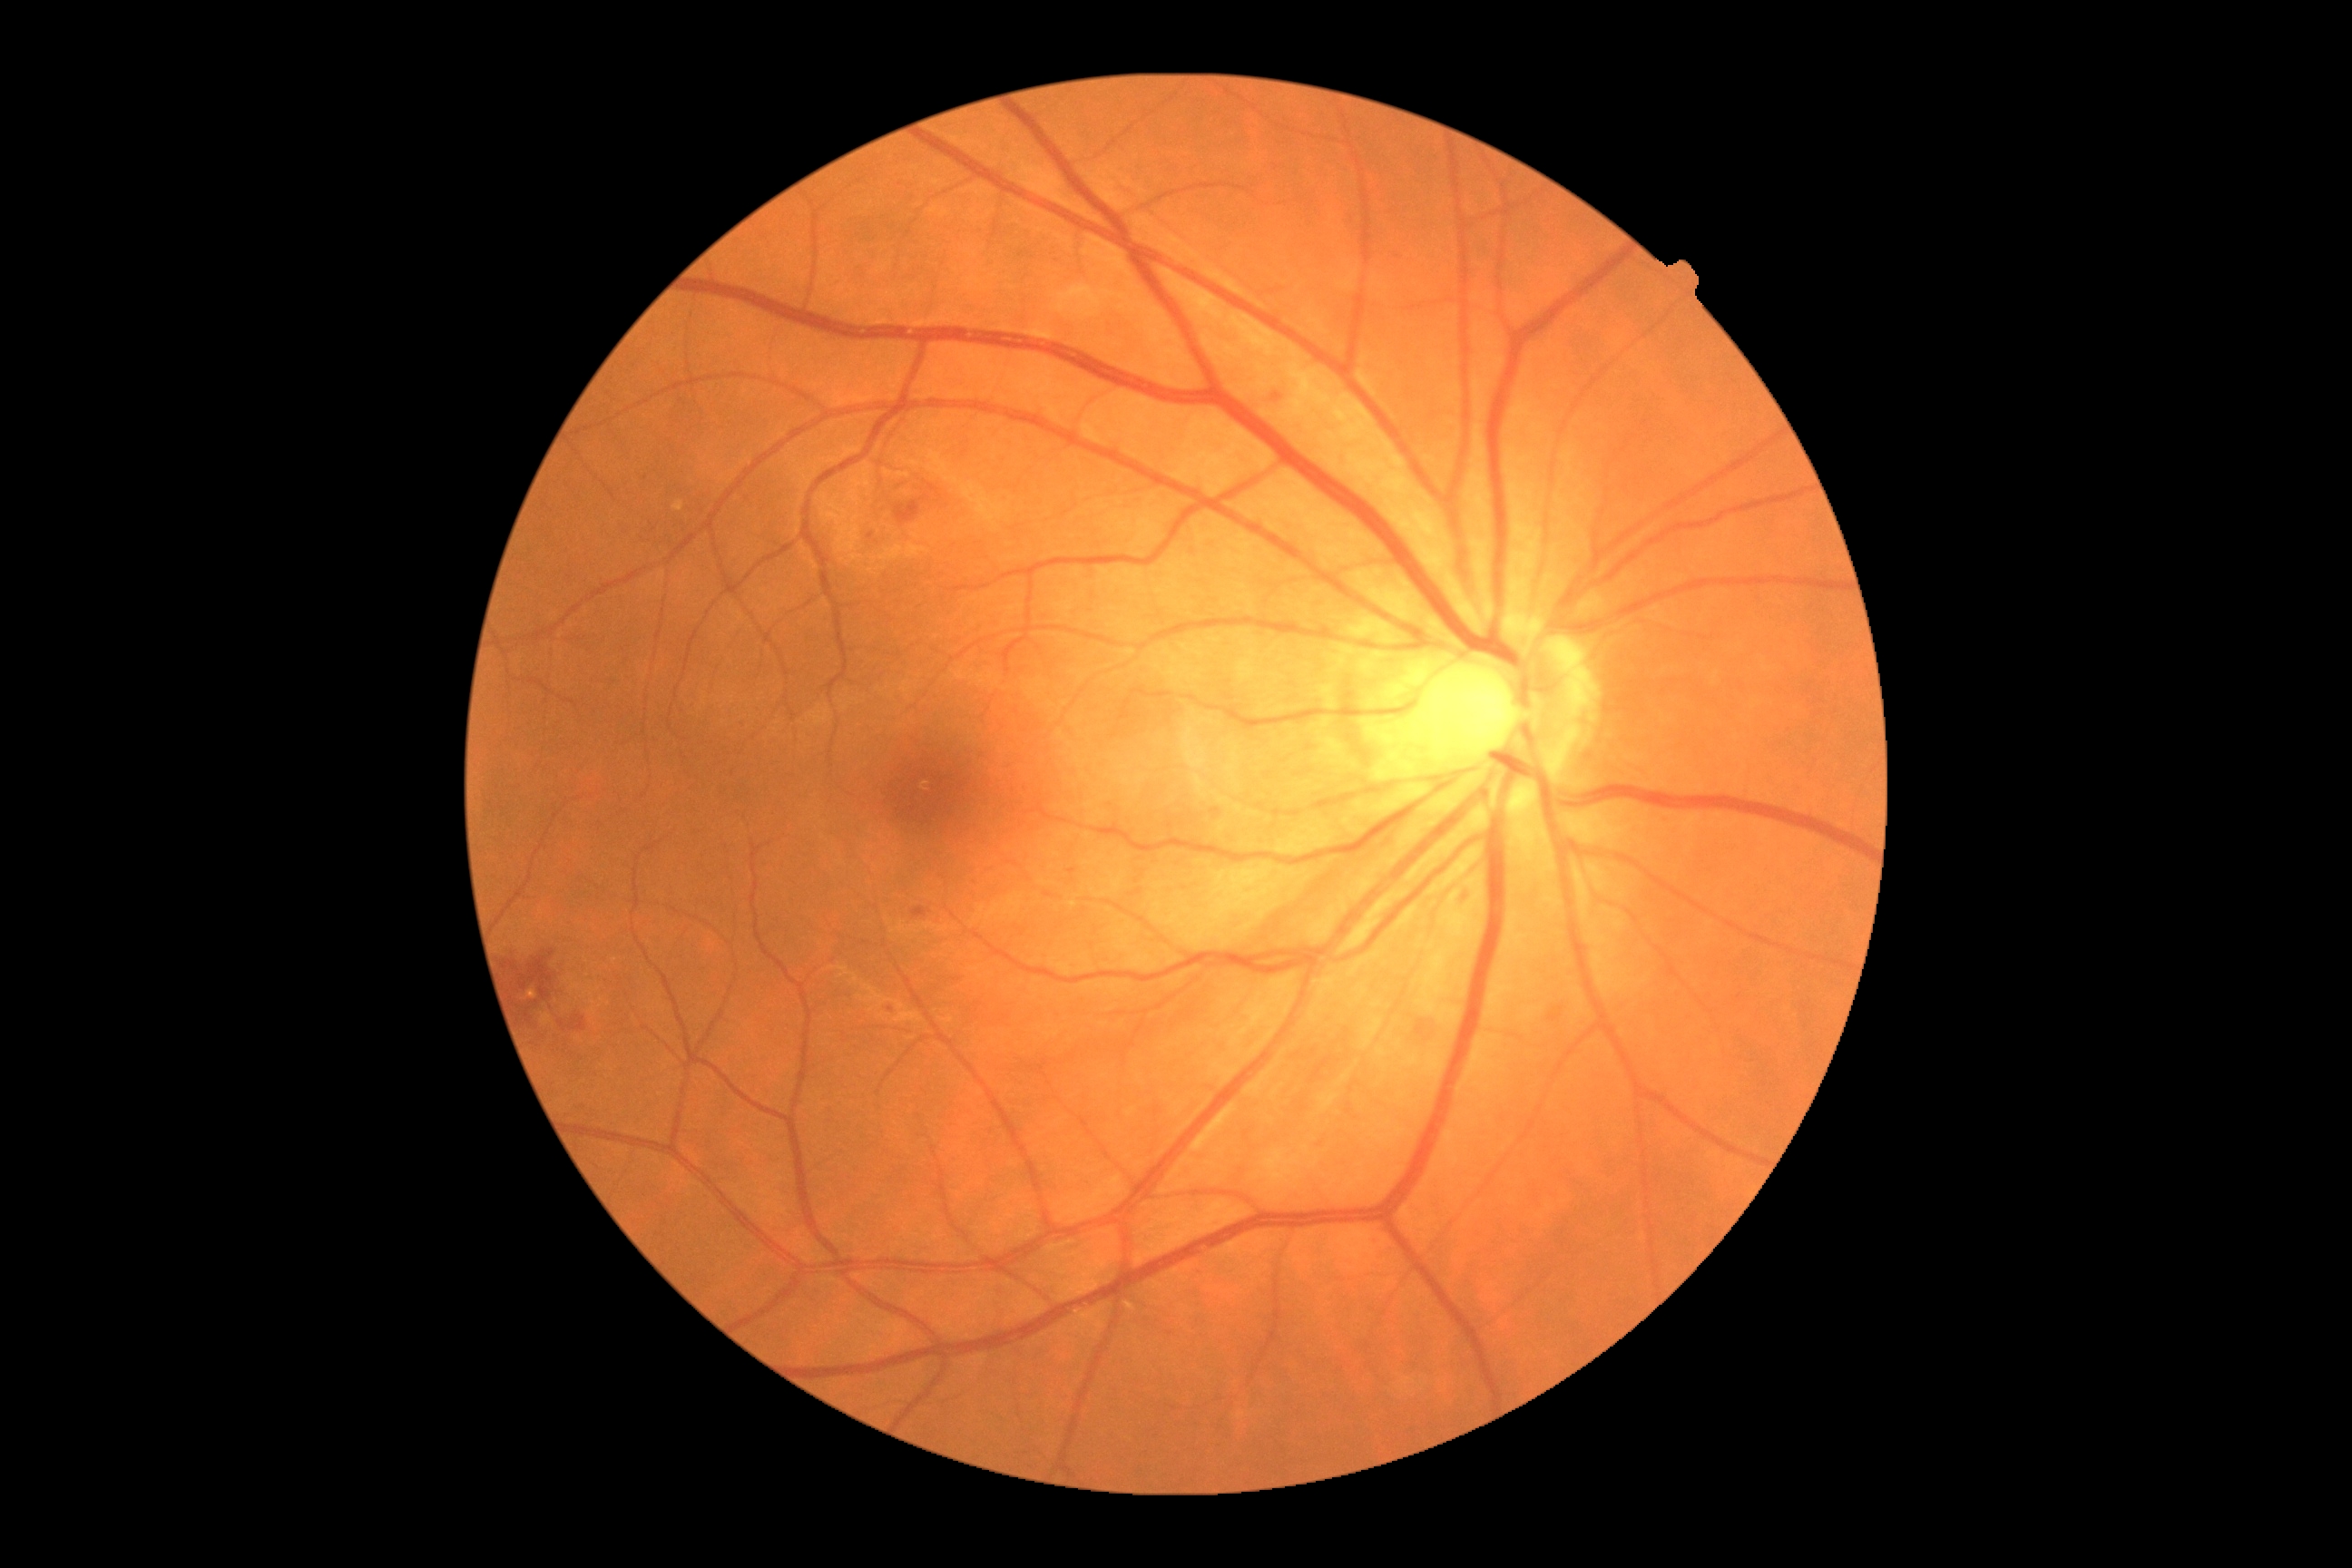

Diabetic retinopathy: moderate NPDR (grade 2). DR class: non-proliferative diabetic retinopathy.